DR severity per modified Davis staging — 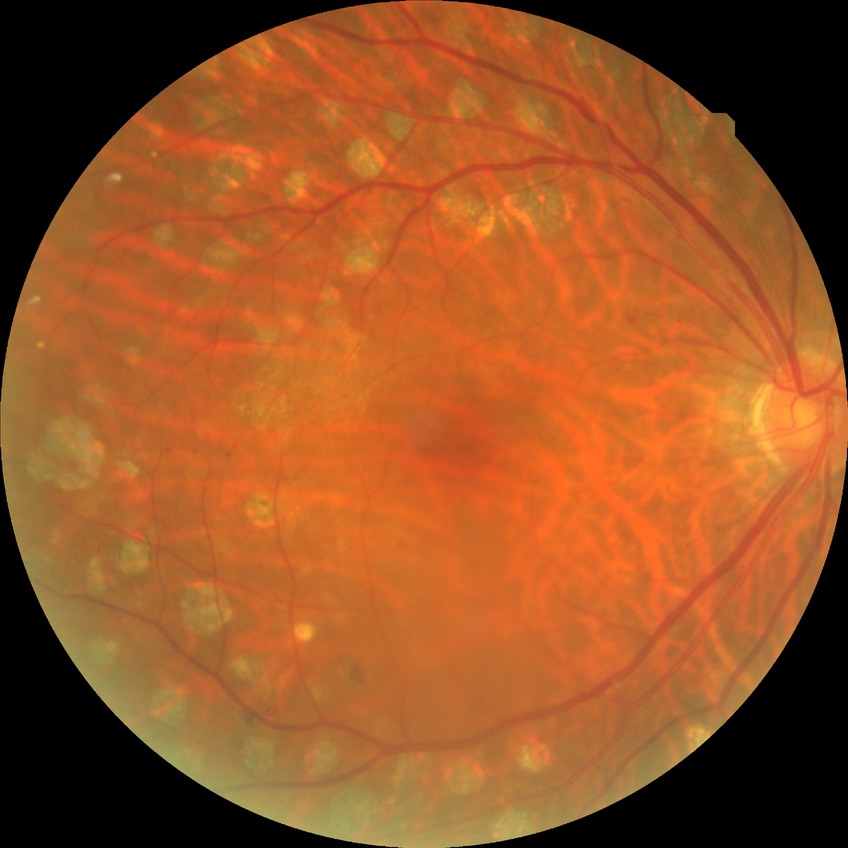 Diabetic retinopathy stage: proliferative diabetic retinopathy.